NIDEK AFC-230 fundus camera. 848x848px — 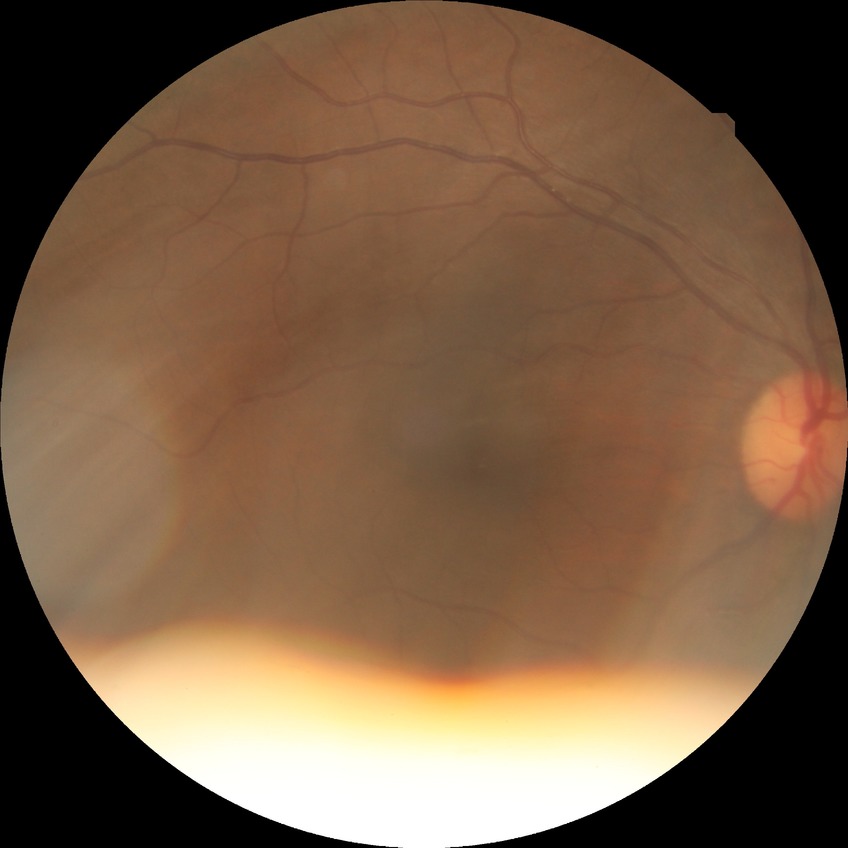
Annotations:
– diabetic retinopathy (DR) — NDR (no diabetic retinopathy)